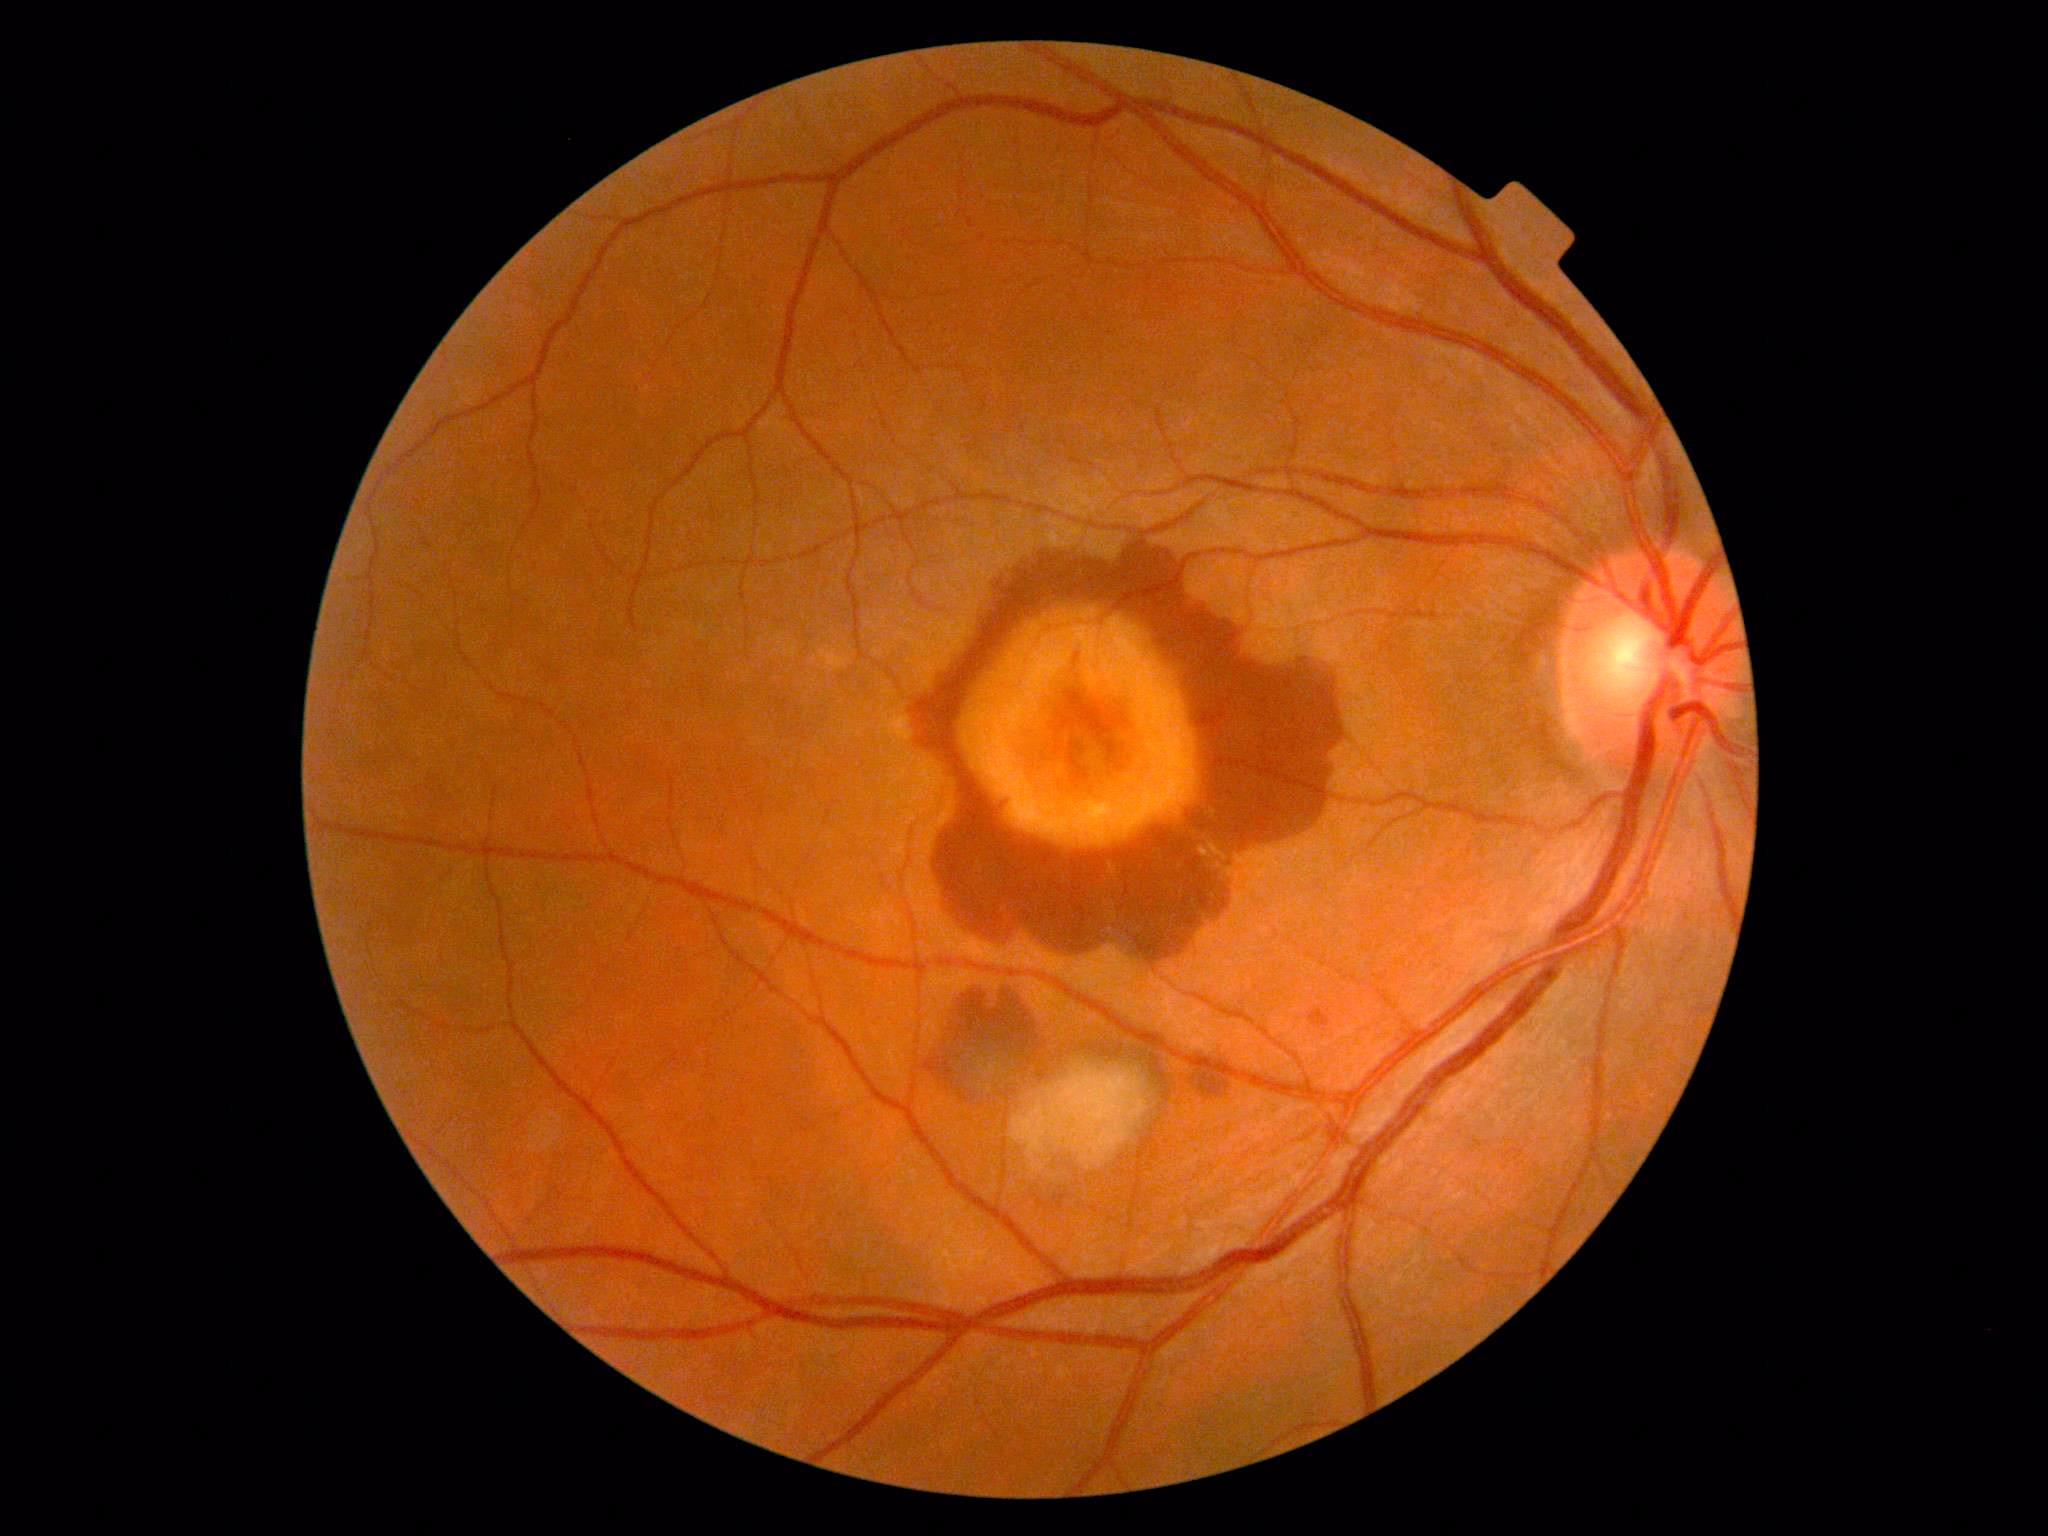 Retinopathy: 4/4.